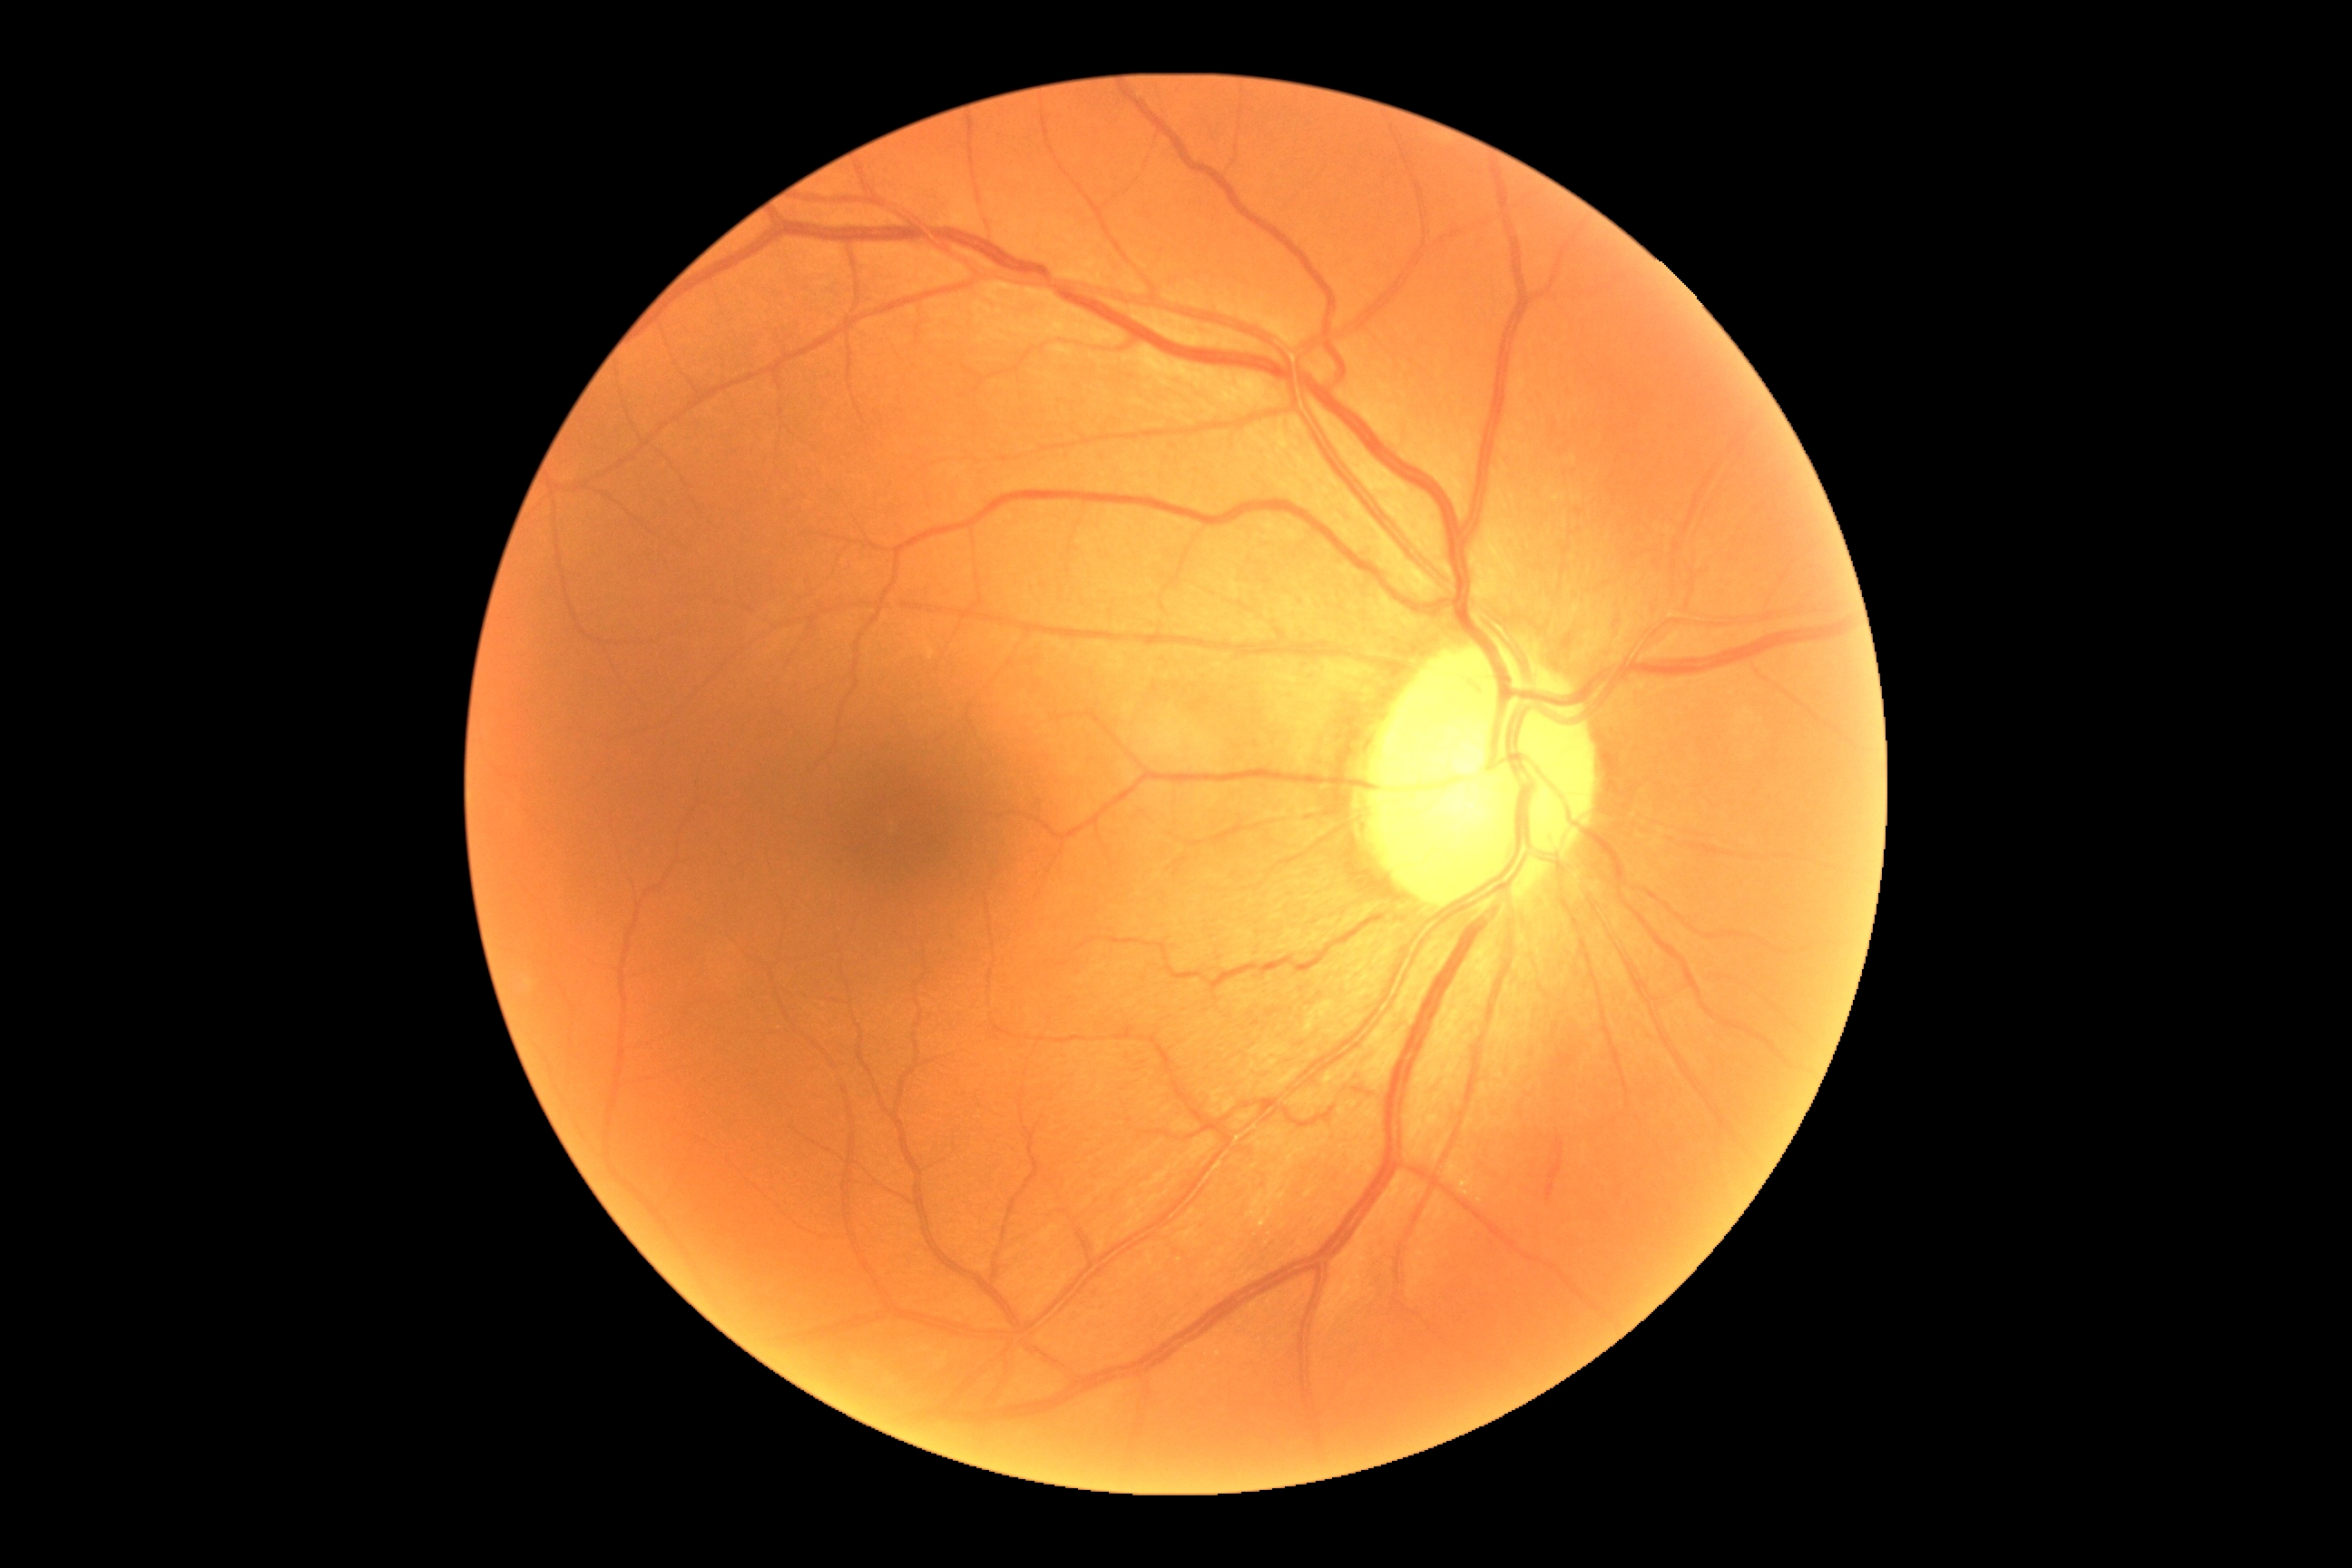
diabetic retinopathy grade = moderate non-proliferative diabetic retinopathy (2)
DR class = non-proliferative diabetic retinopathy